1440 x 1080 pixels; wide-field fundus photograph of an infant: 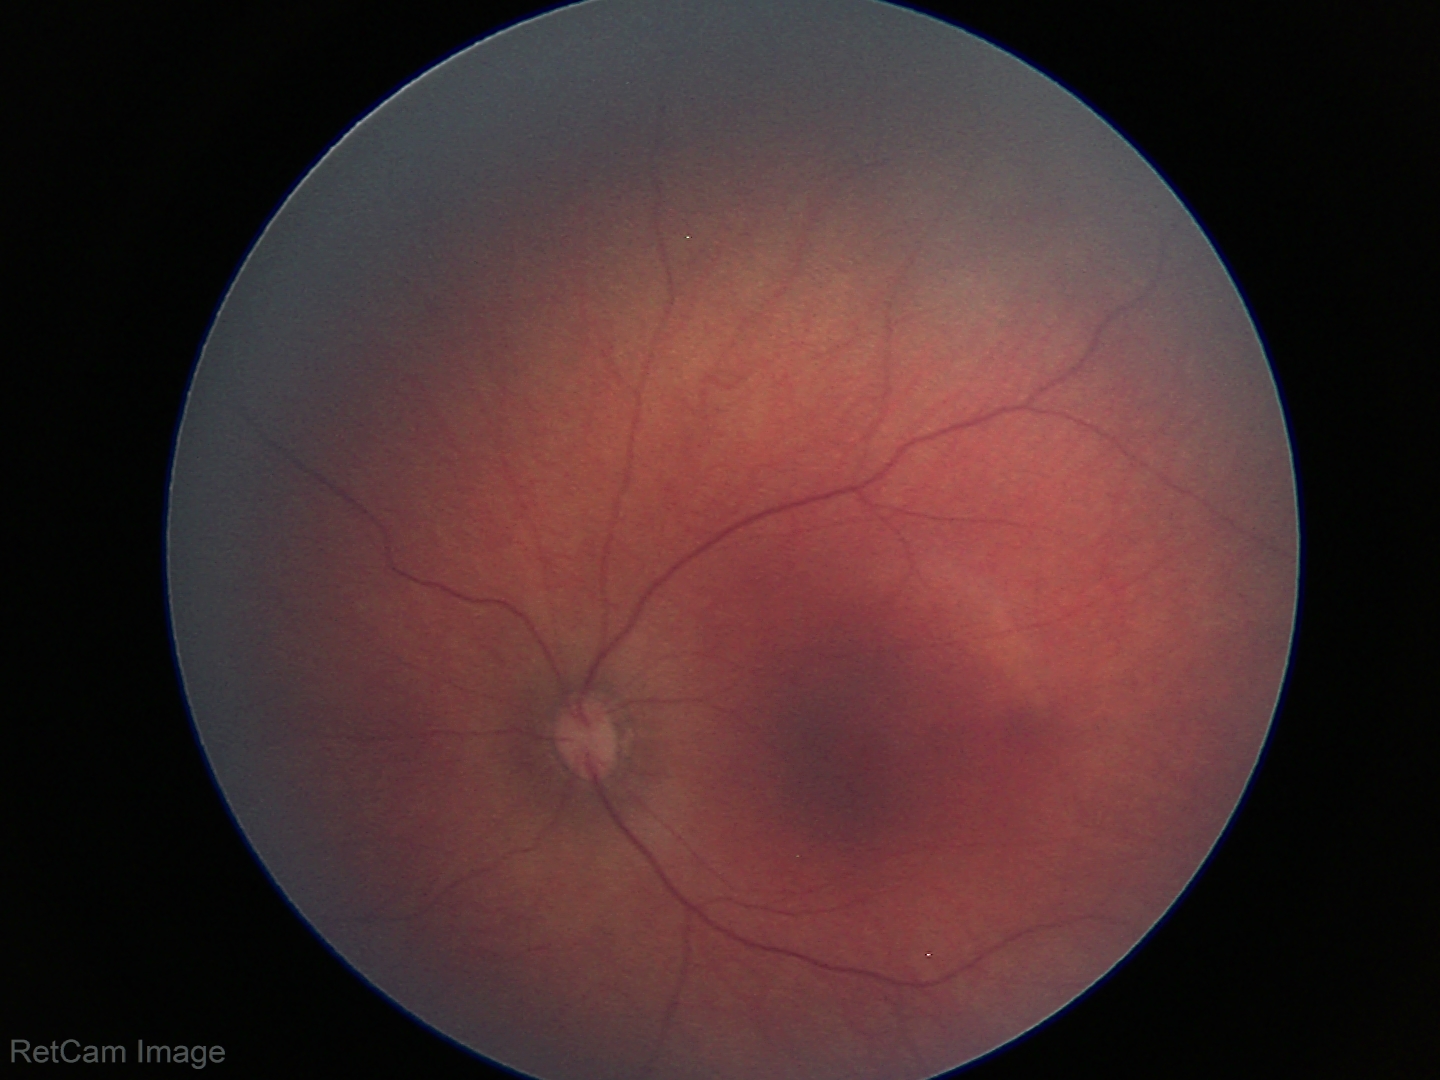
Examination with physiological retinal findings.